Wide-field fundus photograph of an infant · captured with the Phoenix ICON (100° field of view) — 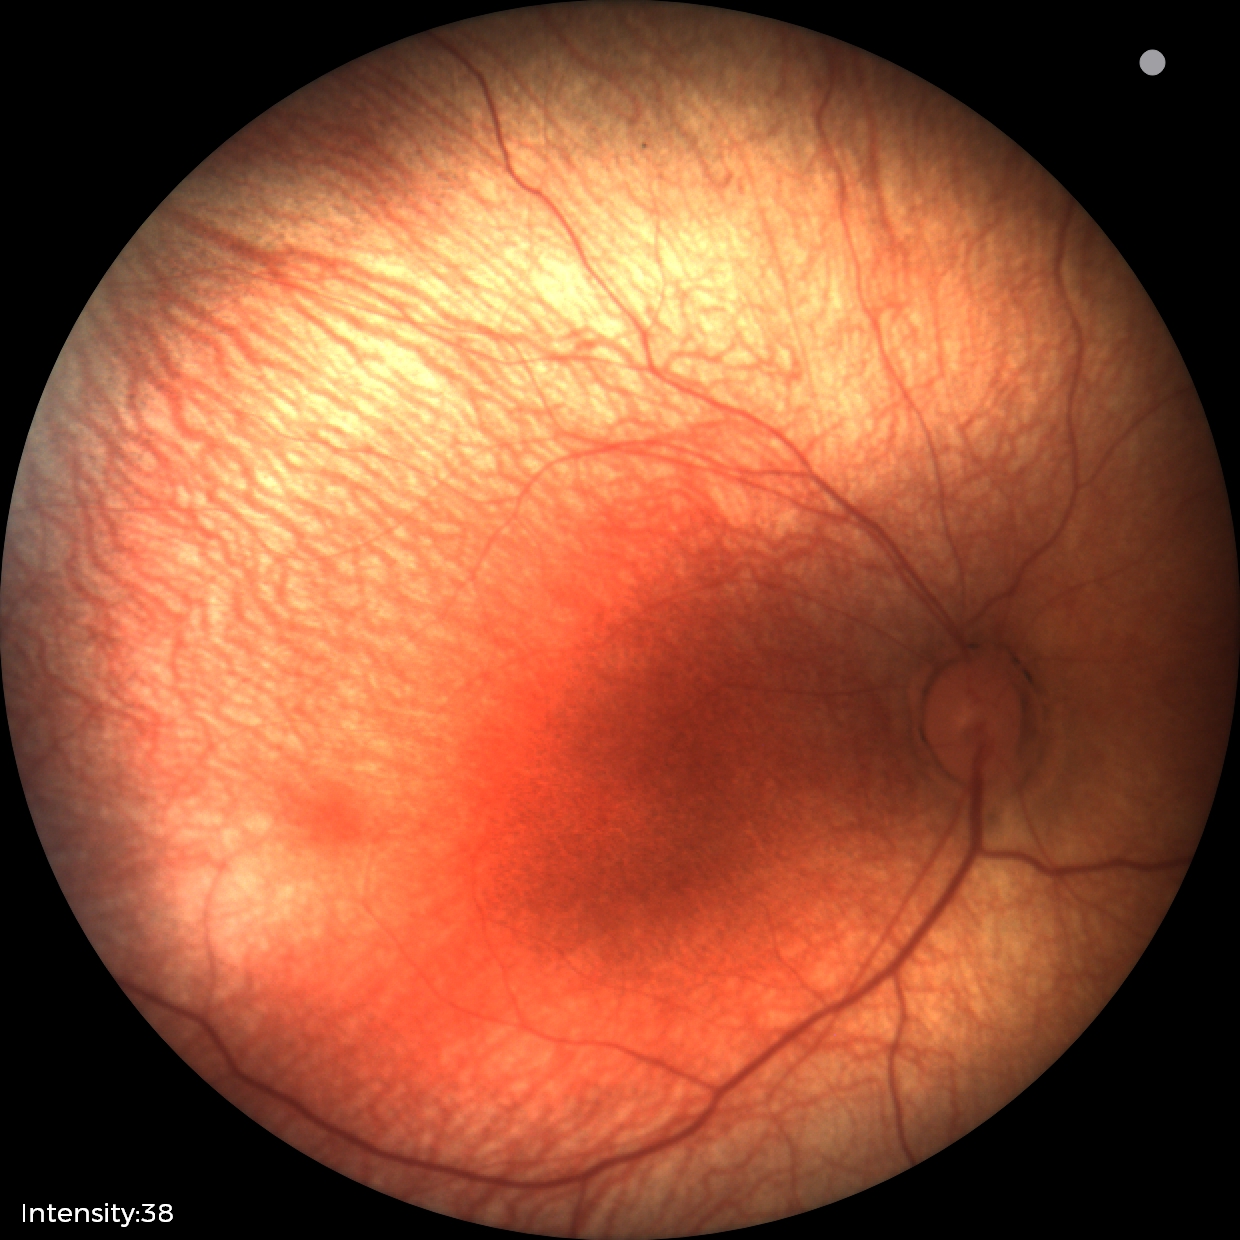

Screening examination with no abnormal retinal findings.